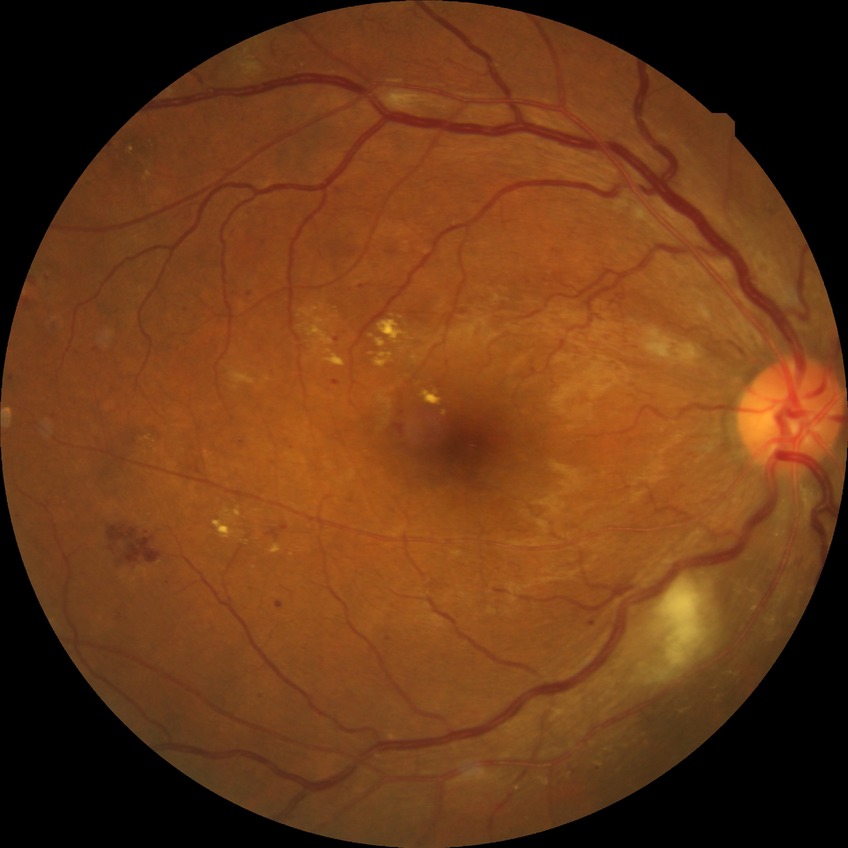

diabetic retinopathy (DR) = pre-proliferative diabetic retinopathy (PPDR).